RetCam wide-field infant fundus image:
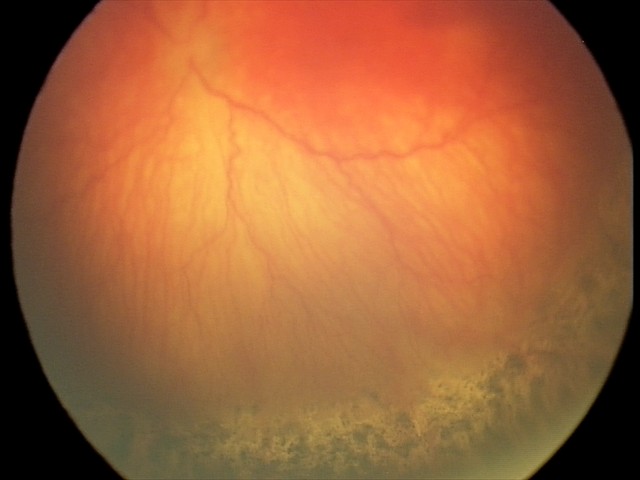 Diagnosis = aggressive retinopathy of prematurity, plus form = present.